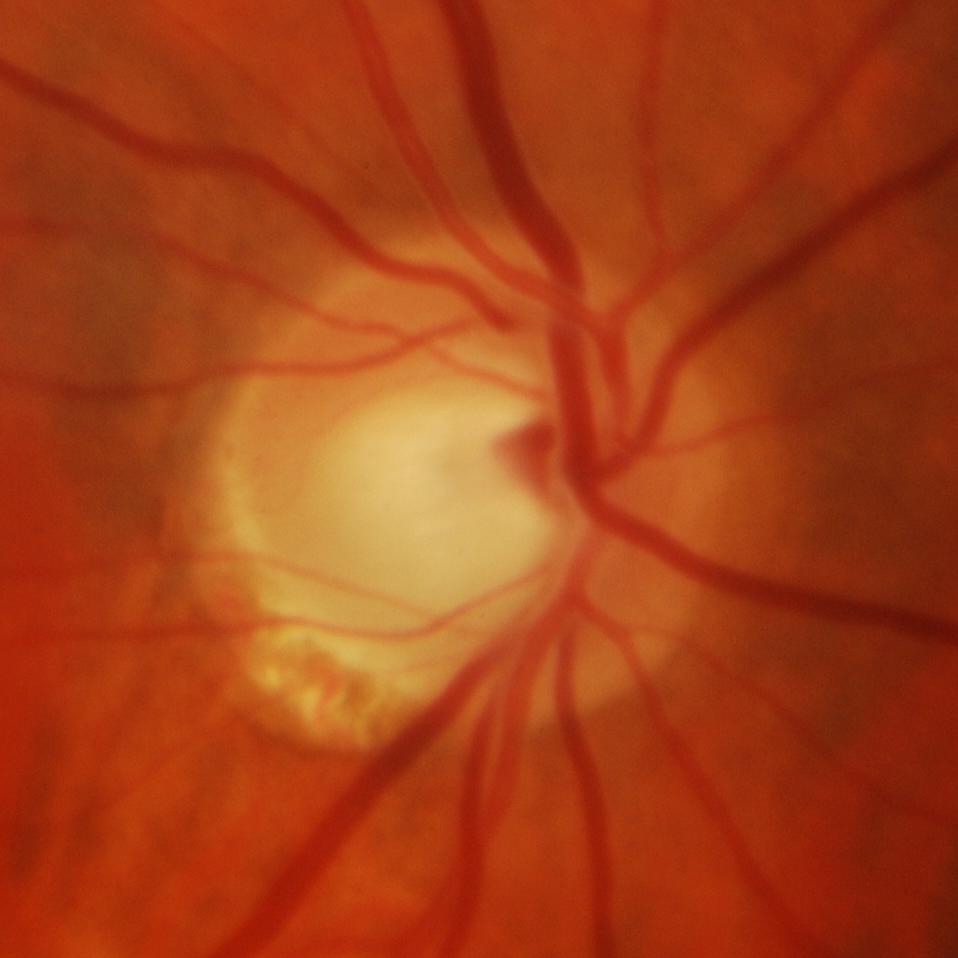
Consistent with glaucomatous findings.